Optic disc-centered crop — 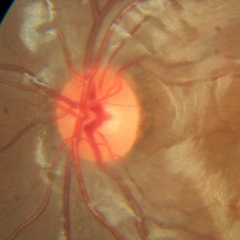
Fundus appearance consistent with no glaucomatous findings.